Fundus image cropped to the optic disc: 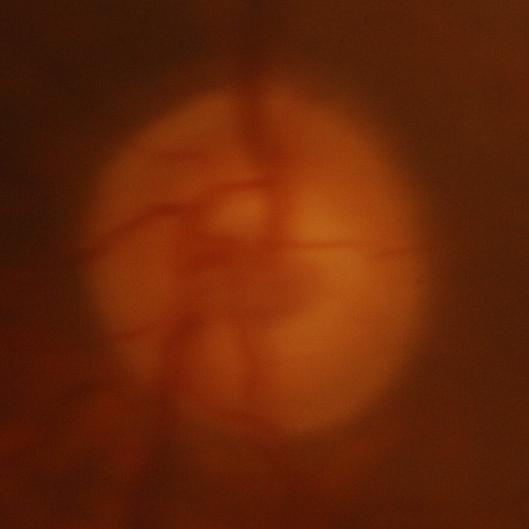
Glaucomatous changes are present. The image shows glaucoma.